Graded on the modified Davis scale; camera: NIDEK AFC-230; CFP; nonmydriatic; 45 degree fundus photograph; 848 by 848 pixels — 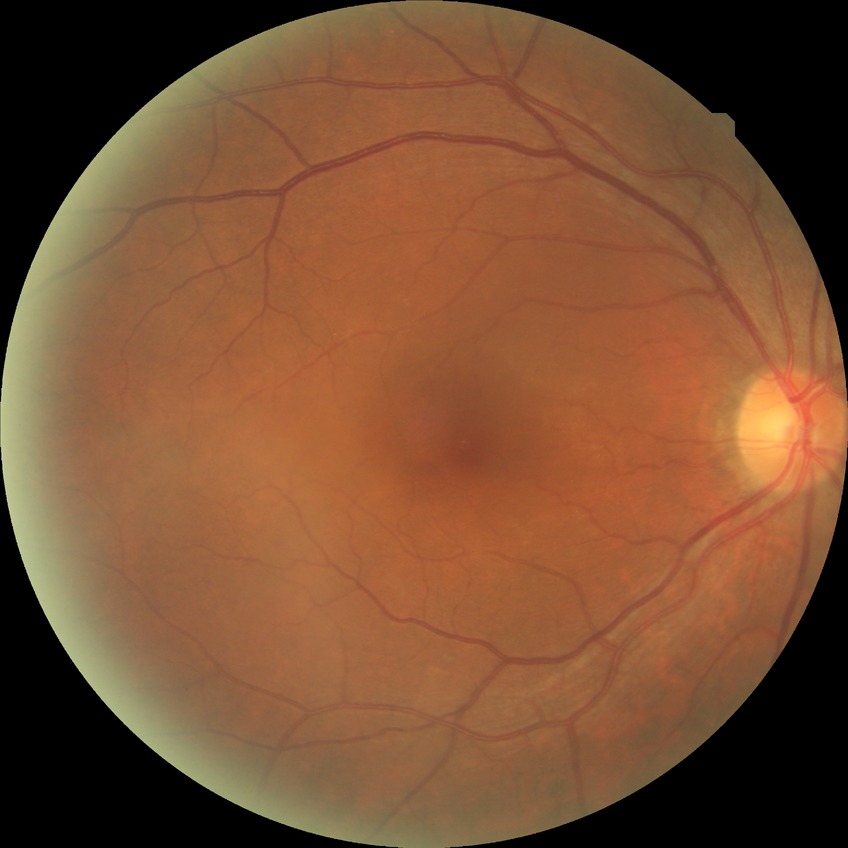 DR impression@negative for DR; DR stage@NDR.